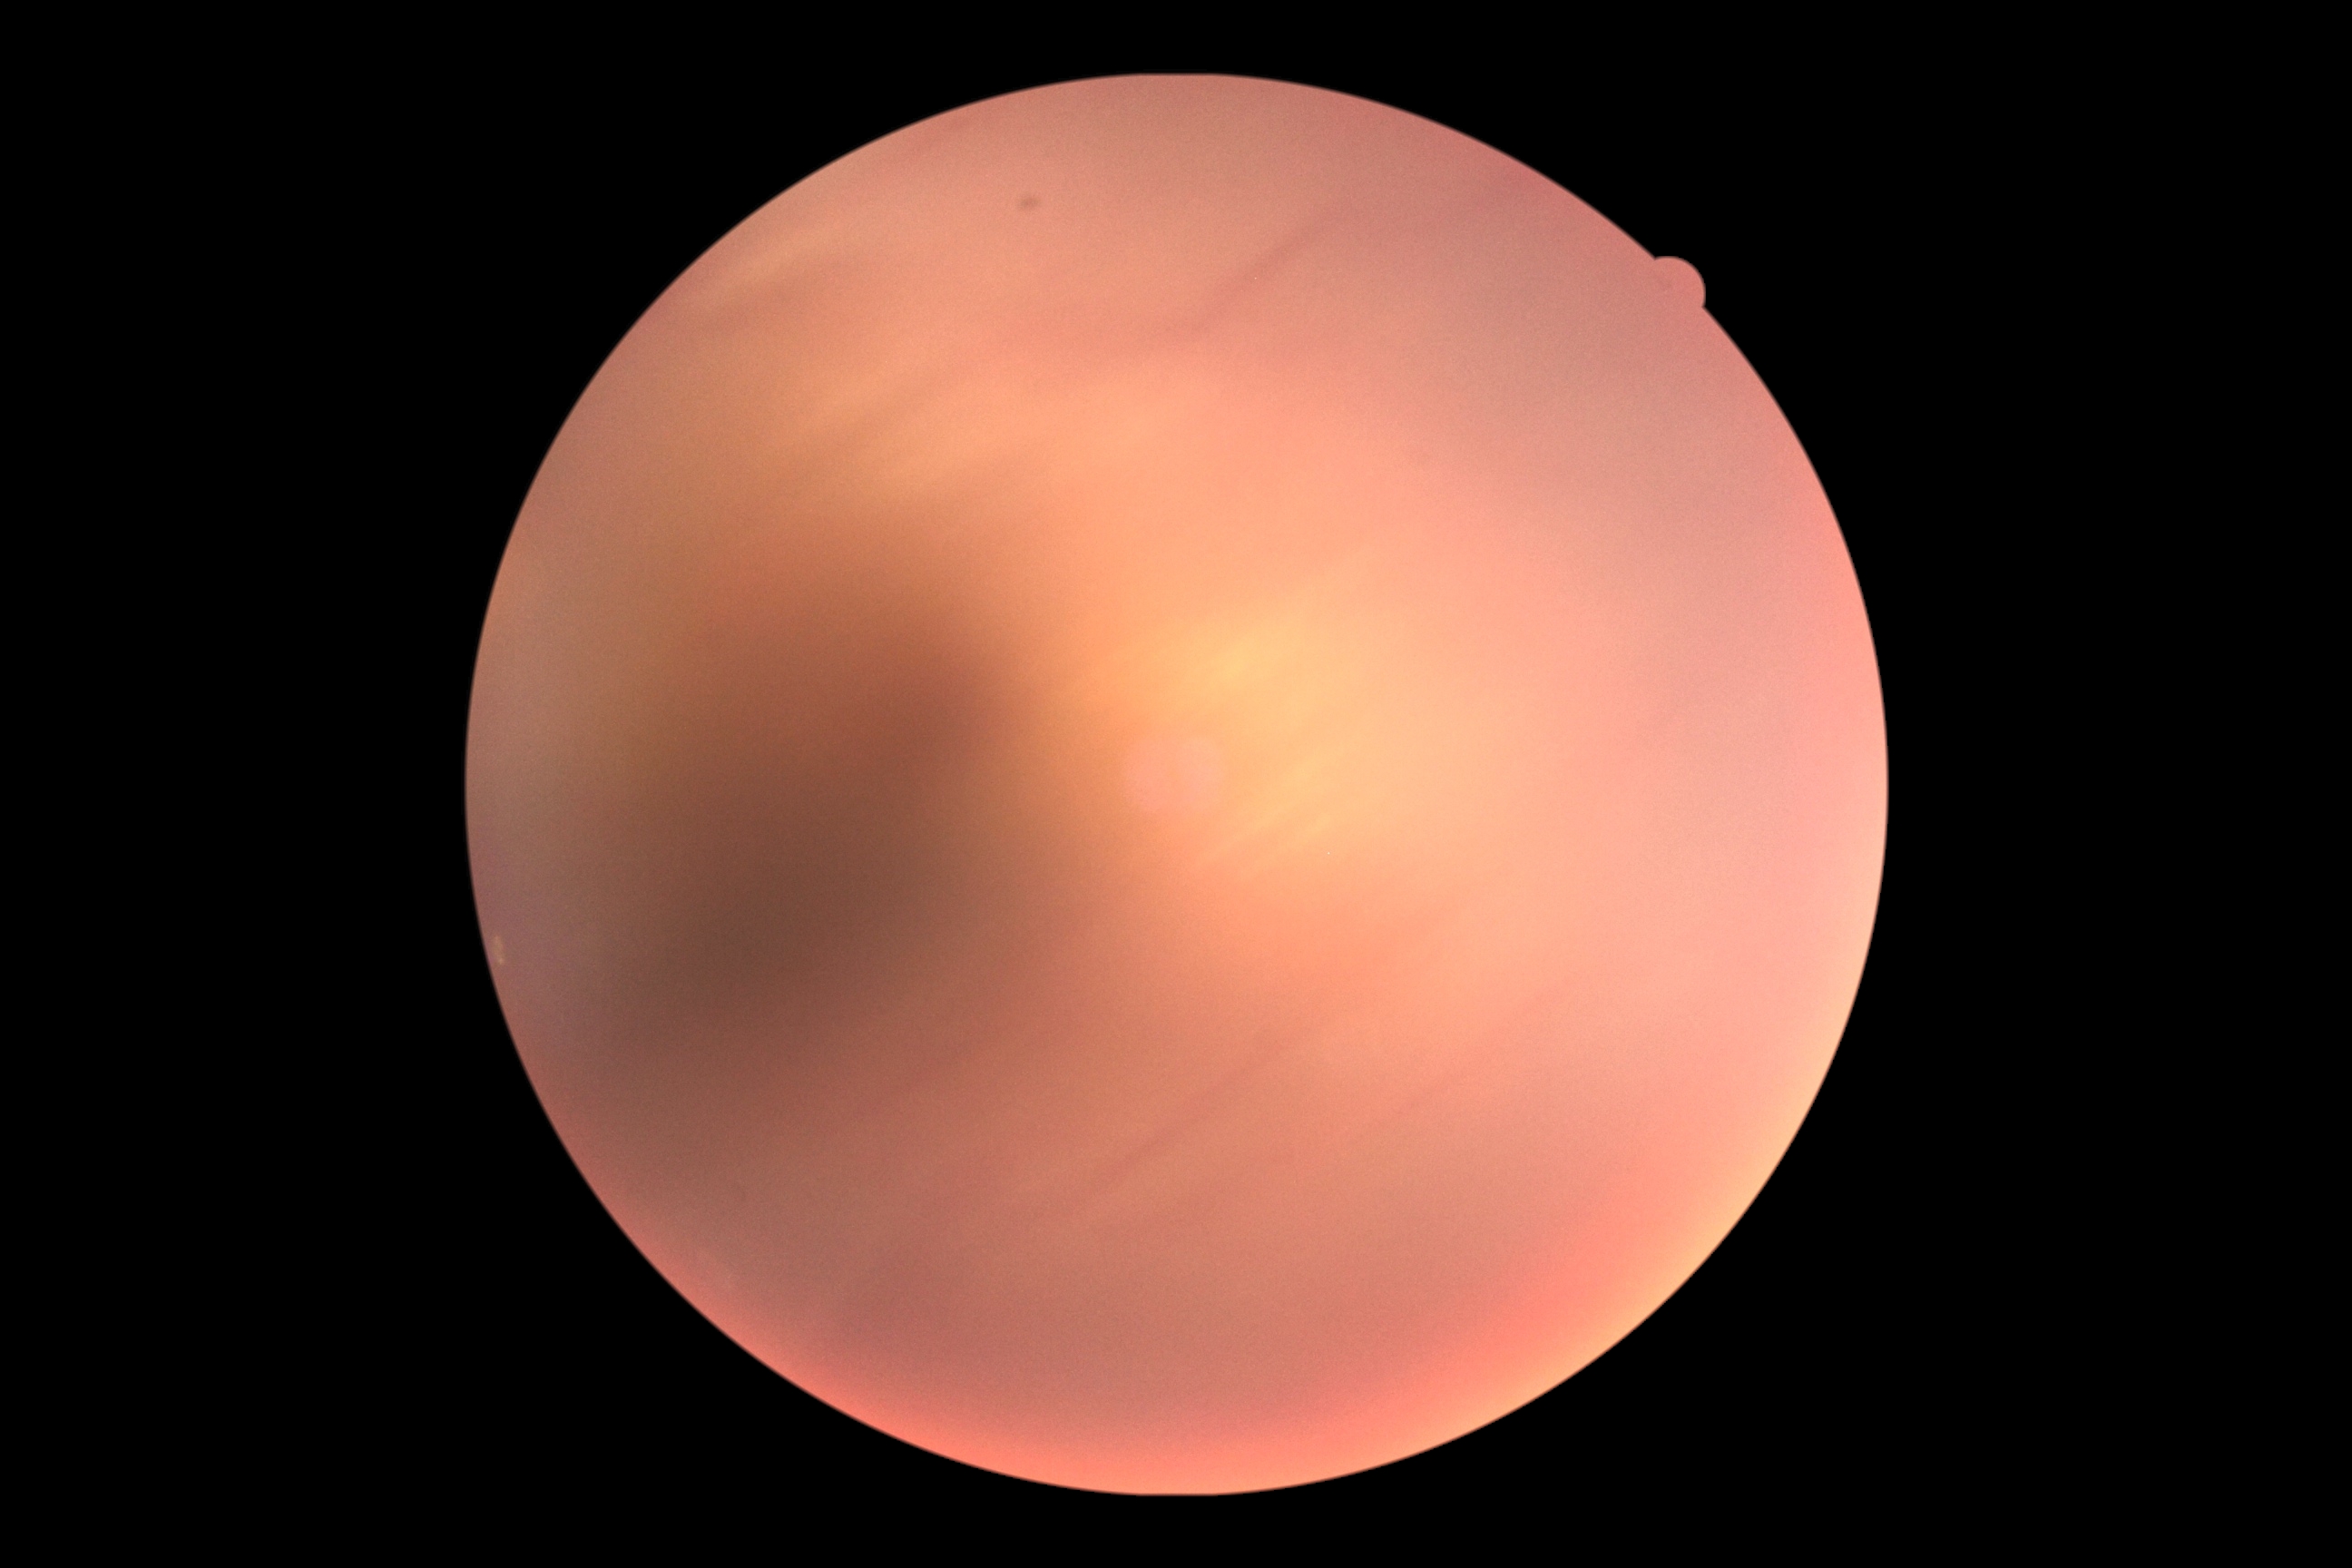

Retinopathy: ungradable due to poor image quality. Quality too poor to assess for DR.